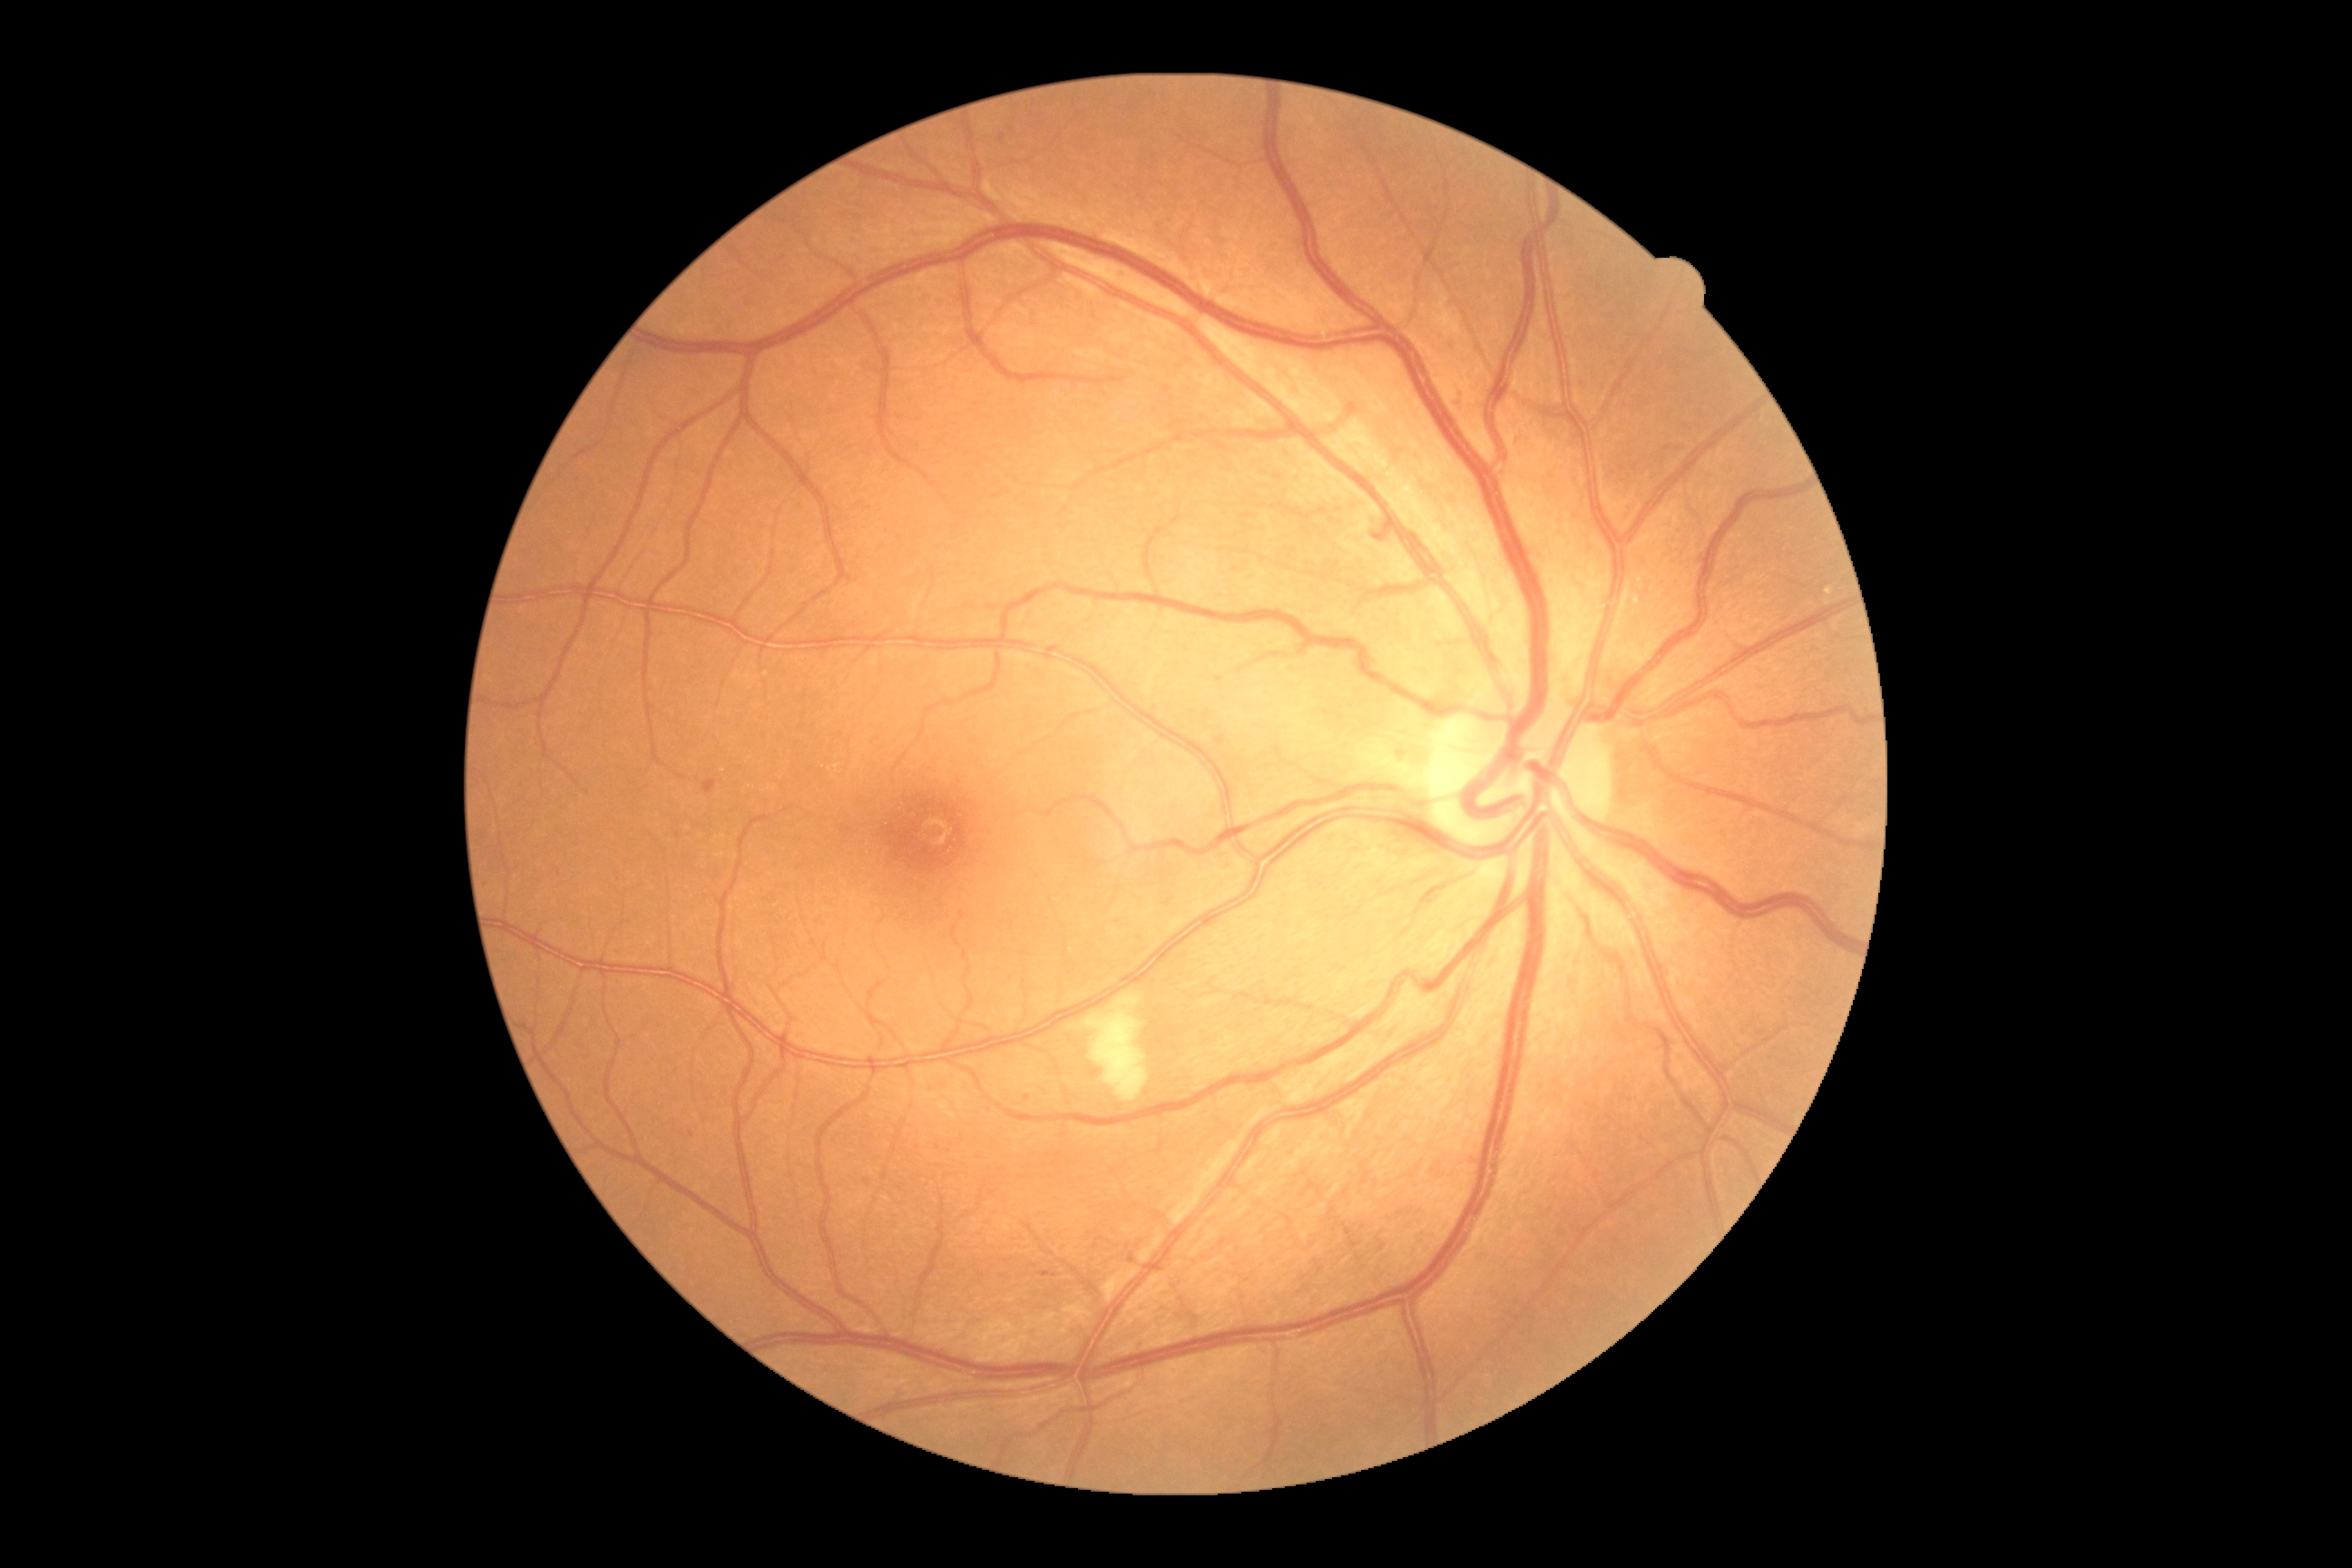 {"partial": true, "dr_grade": 2, "dr_grade_name": "moderate NPDR", "lesions": {"ex": null, "se": [[1086, 992, 1150, 1101]], "he": null, "ma": [[1041, 1271, 1054, 1279], [1582, 378, 1592, 387], [1215, 738, 1224, 747], [1458, 393, 1465, 402], [1444, 342, 1455, 351], [703, 779, 718, 796]], "ma_small_approx": [[866, 1182], [1027, 1098], [1668, 449], [691, 1134]]}}